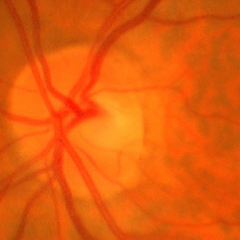 Q: What stage of glaucoma is present?
A: Early glaucomatous optic neuropathy. Diagnostic criteria: glaucomatous retinal nerve fiber layer defects on red-free fundus photography without visual field defects.